Fundus photo; graded on the modified Davis scale; NIDEK AFC-230 fundus camera: 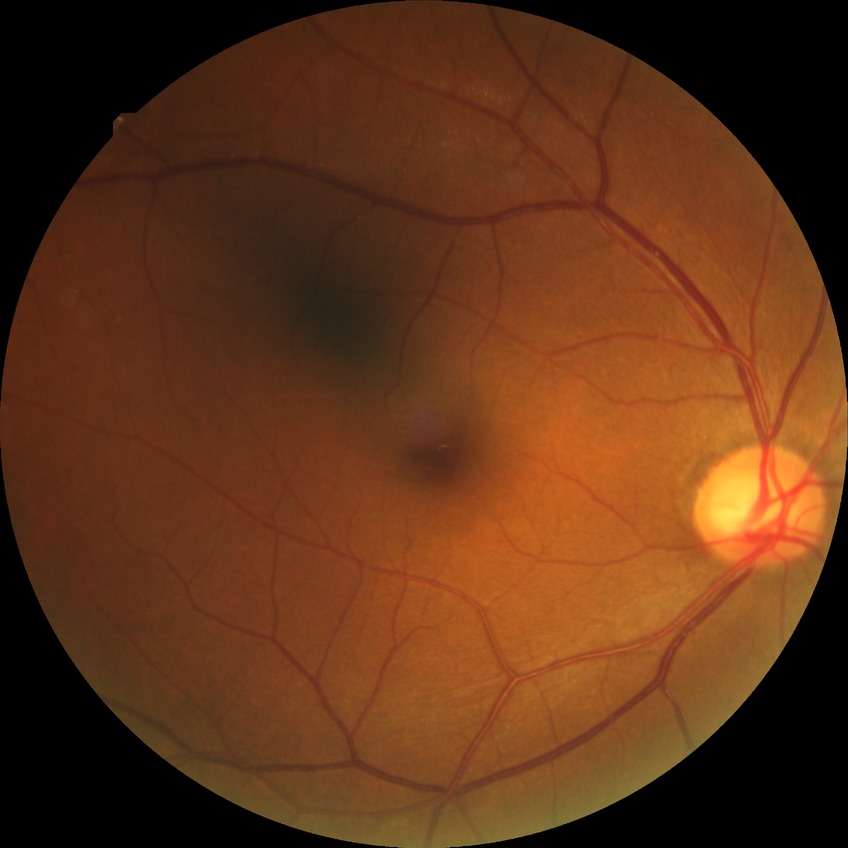 No signs of diabetic retinopathy.
DR severity is NDR.